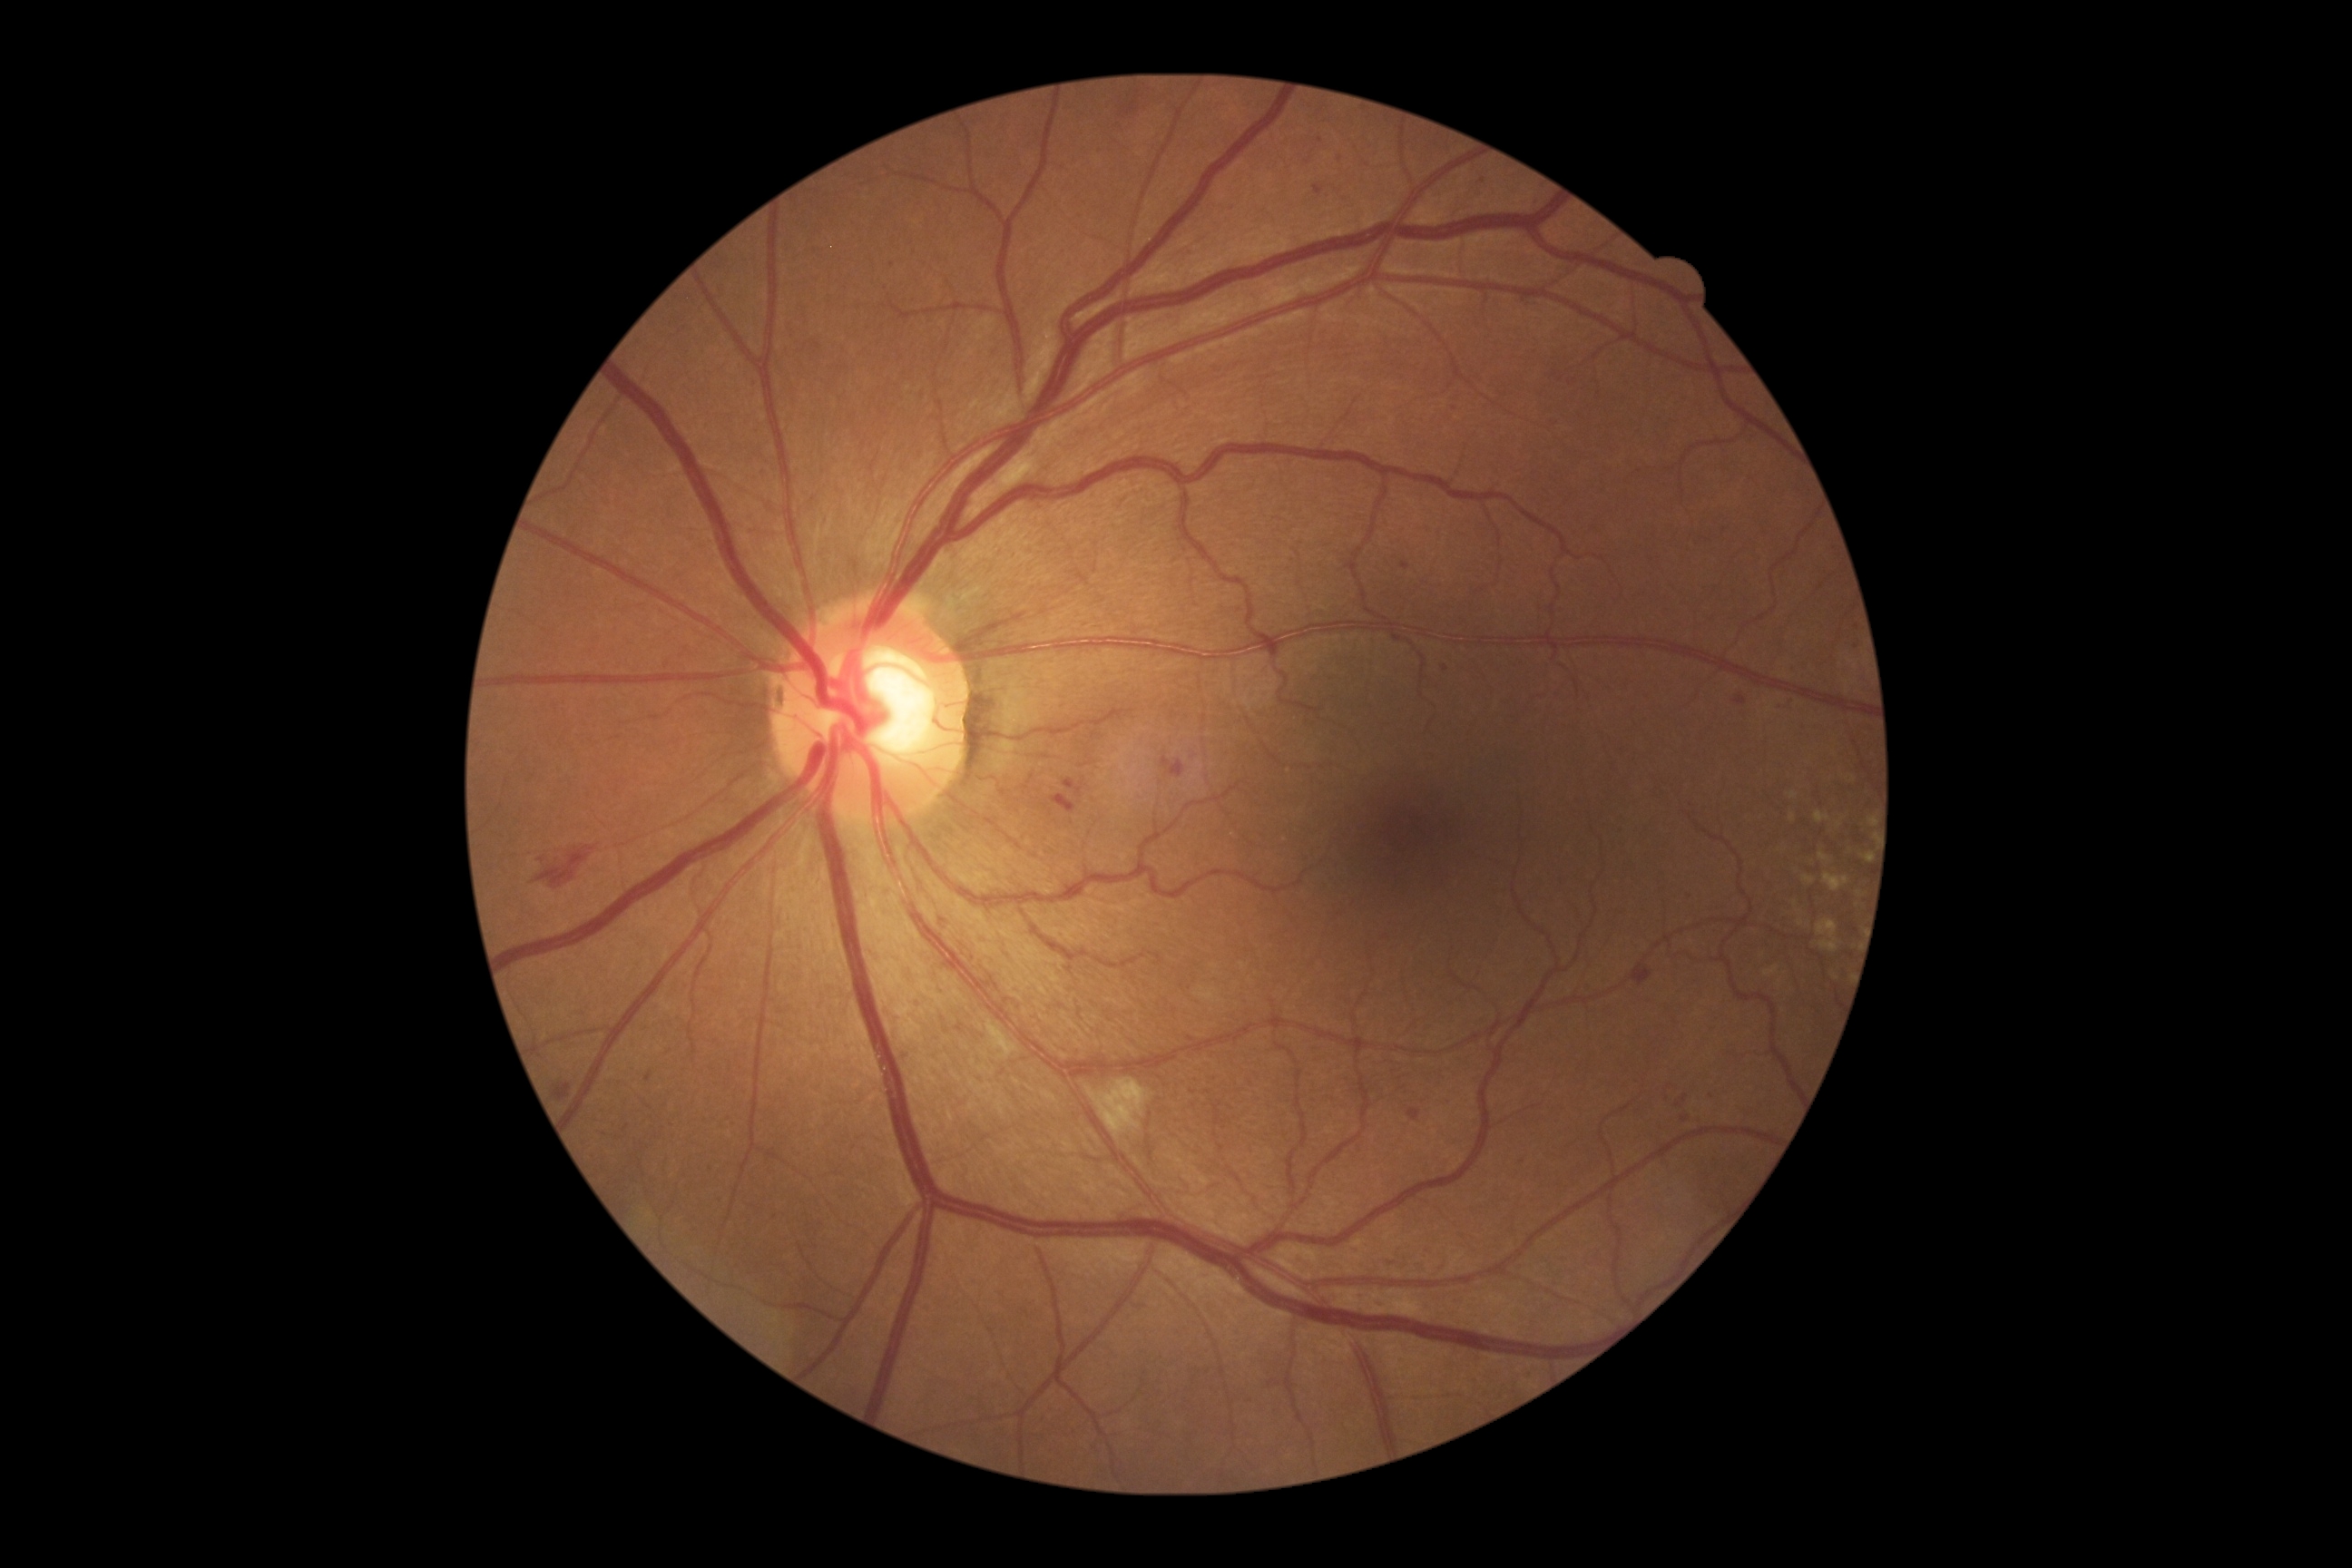
partial: true
dr_grade: 2
dr_grade_name: moderate NPDR
lesions:
  ma:
    - [x1=1779, y1=701, x2=1796, y2=712]
    - [x1=1685, y1=897, x2=1694, y2=905]
    - [x1=1377, y1=1302, x2=1386, y2=1309]
    - [x1=1734, y1=696, x2=1747, y2=705]
    - [x1=1681, y1=1117, x2=1689, y2=1122]
    - [x1=645, y1=1072, x2=652, y2=1084]
  ma_small_centers:
    - x=1679, y=1105
    - x=1446, y=669
    - x=1236, y=608
    - x=1712, y=1097
    - x=542, y=860
    - x=1308, y=163